Fundus photo:
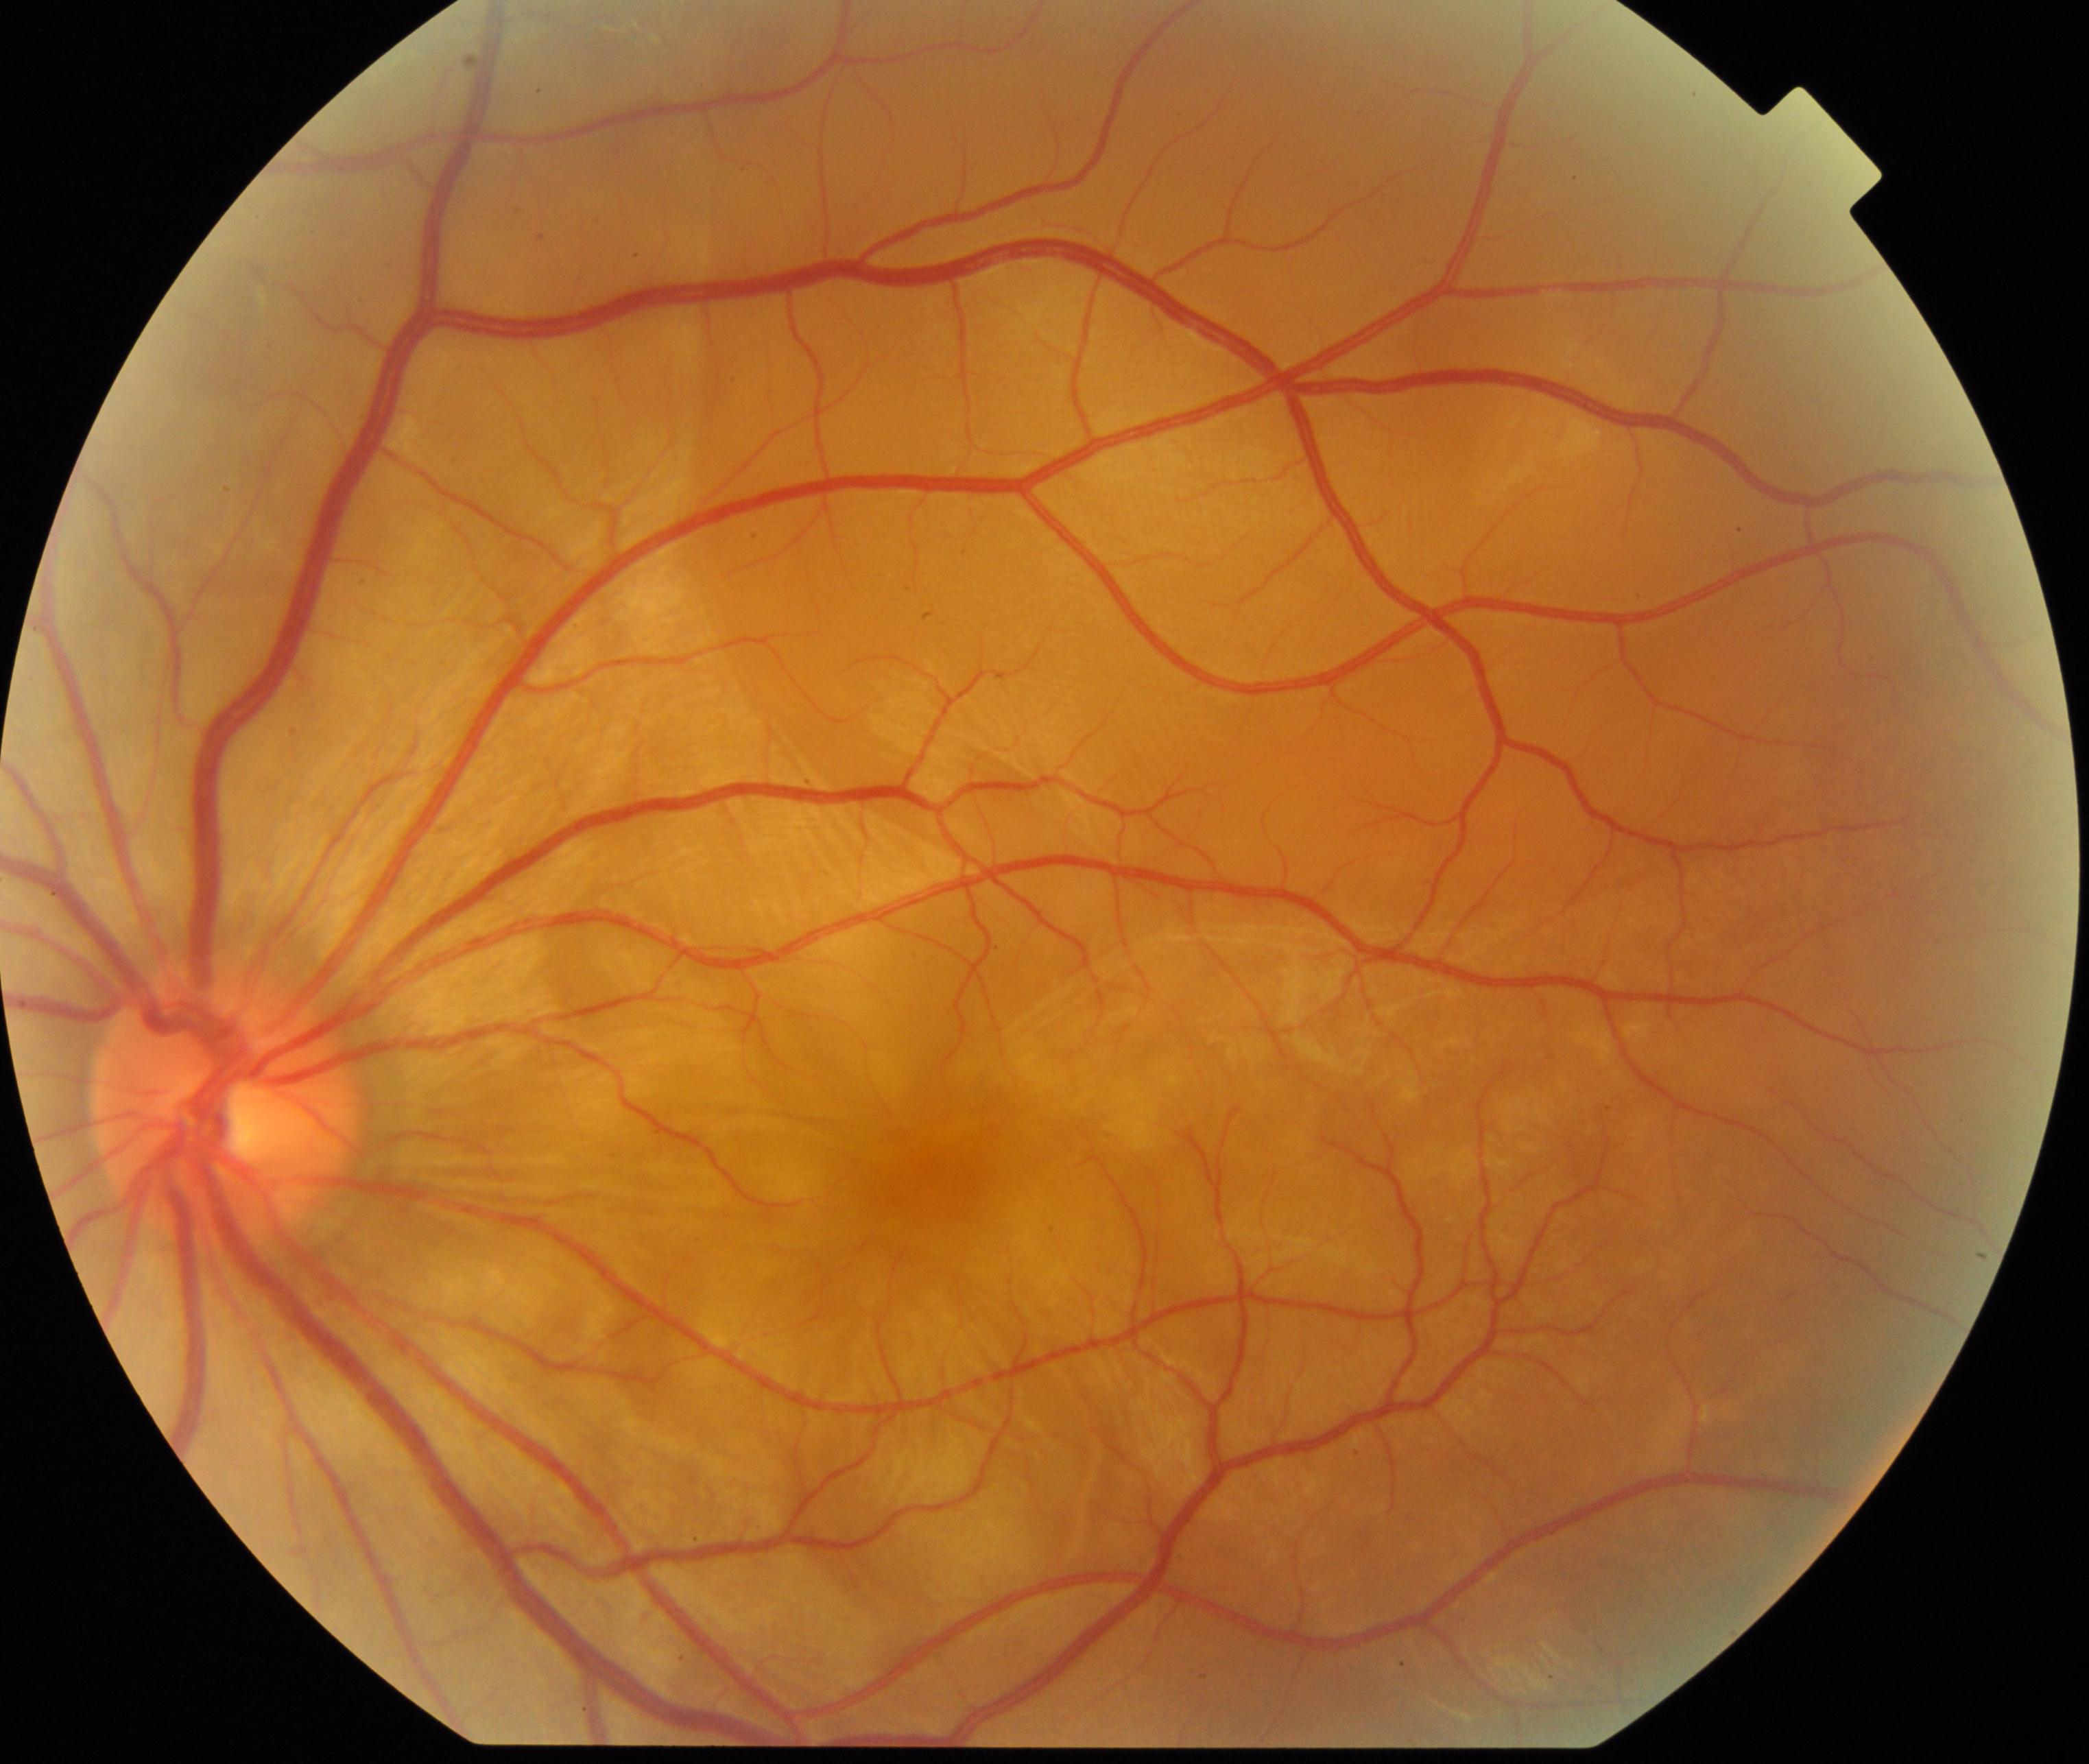

There is evidence of Vogt-Koyanagi-Harada disease (VKH). Defined by circumscribed retinal edema with multiple exudative retinal detachments of the posterior retina, often with optic disc hyperemia and edema; an obscure retina with slight radial folds can be seen as the edema resolves.